FOV: 45 degrees:
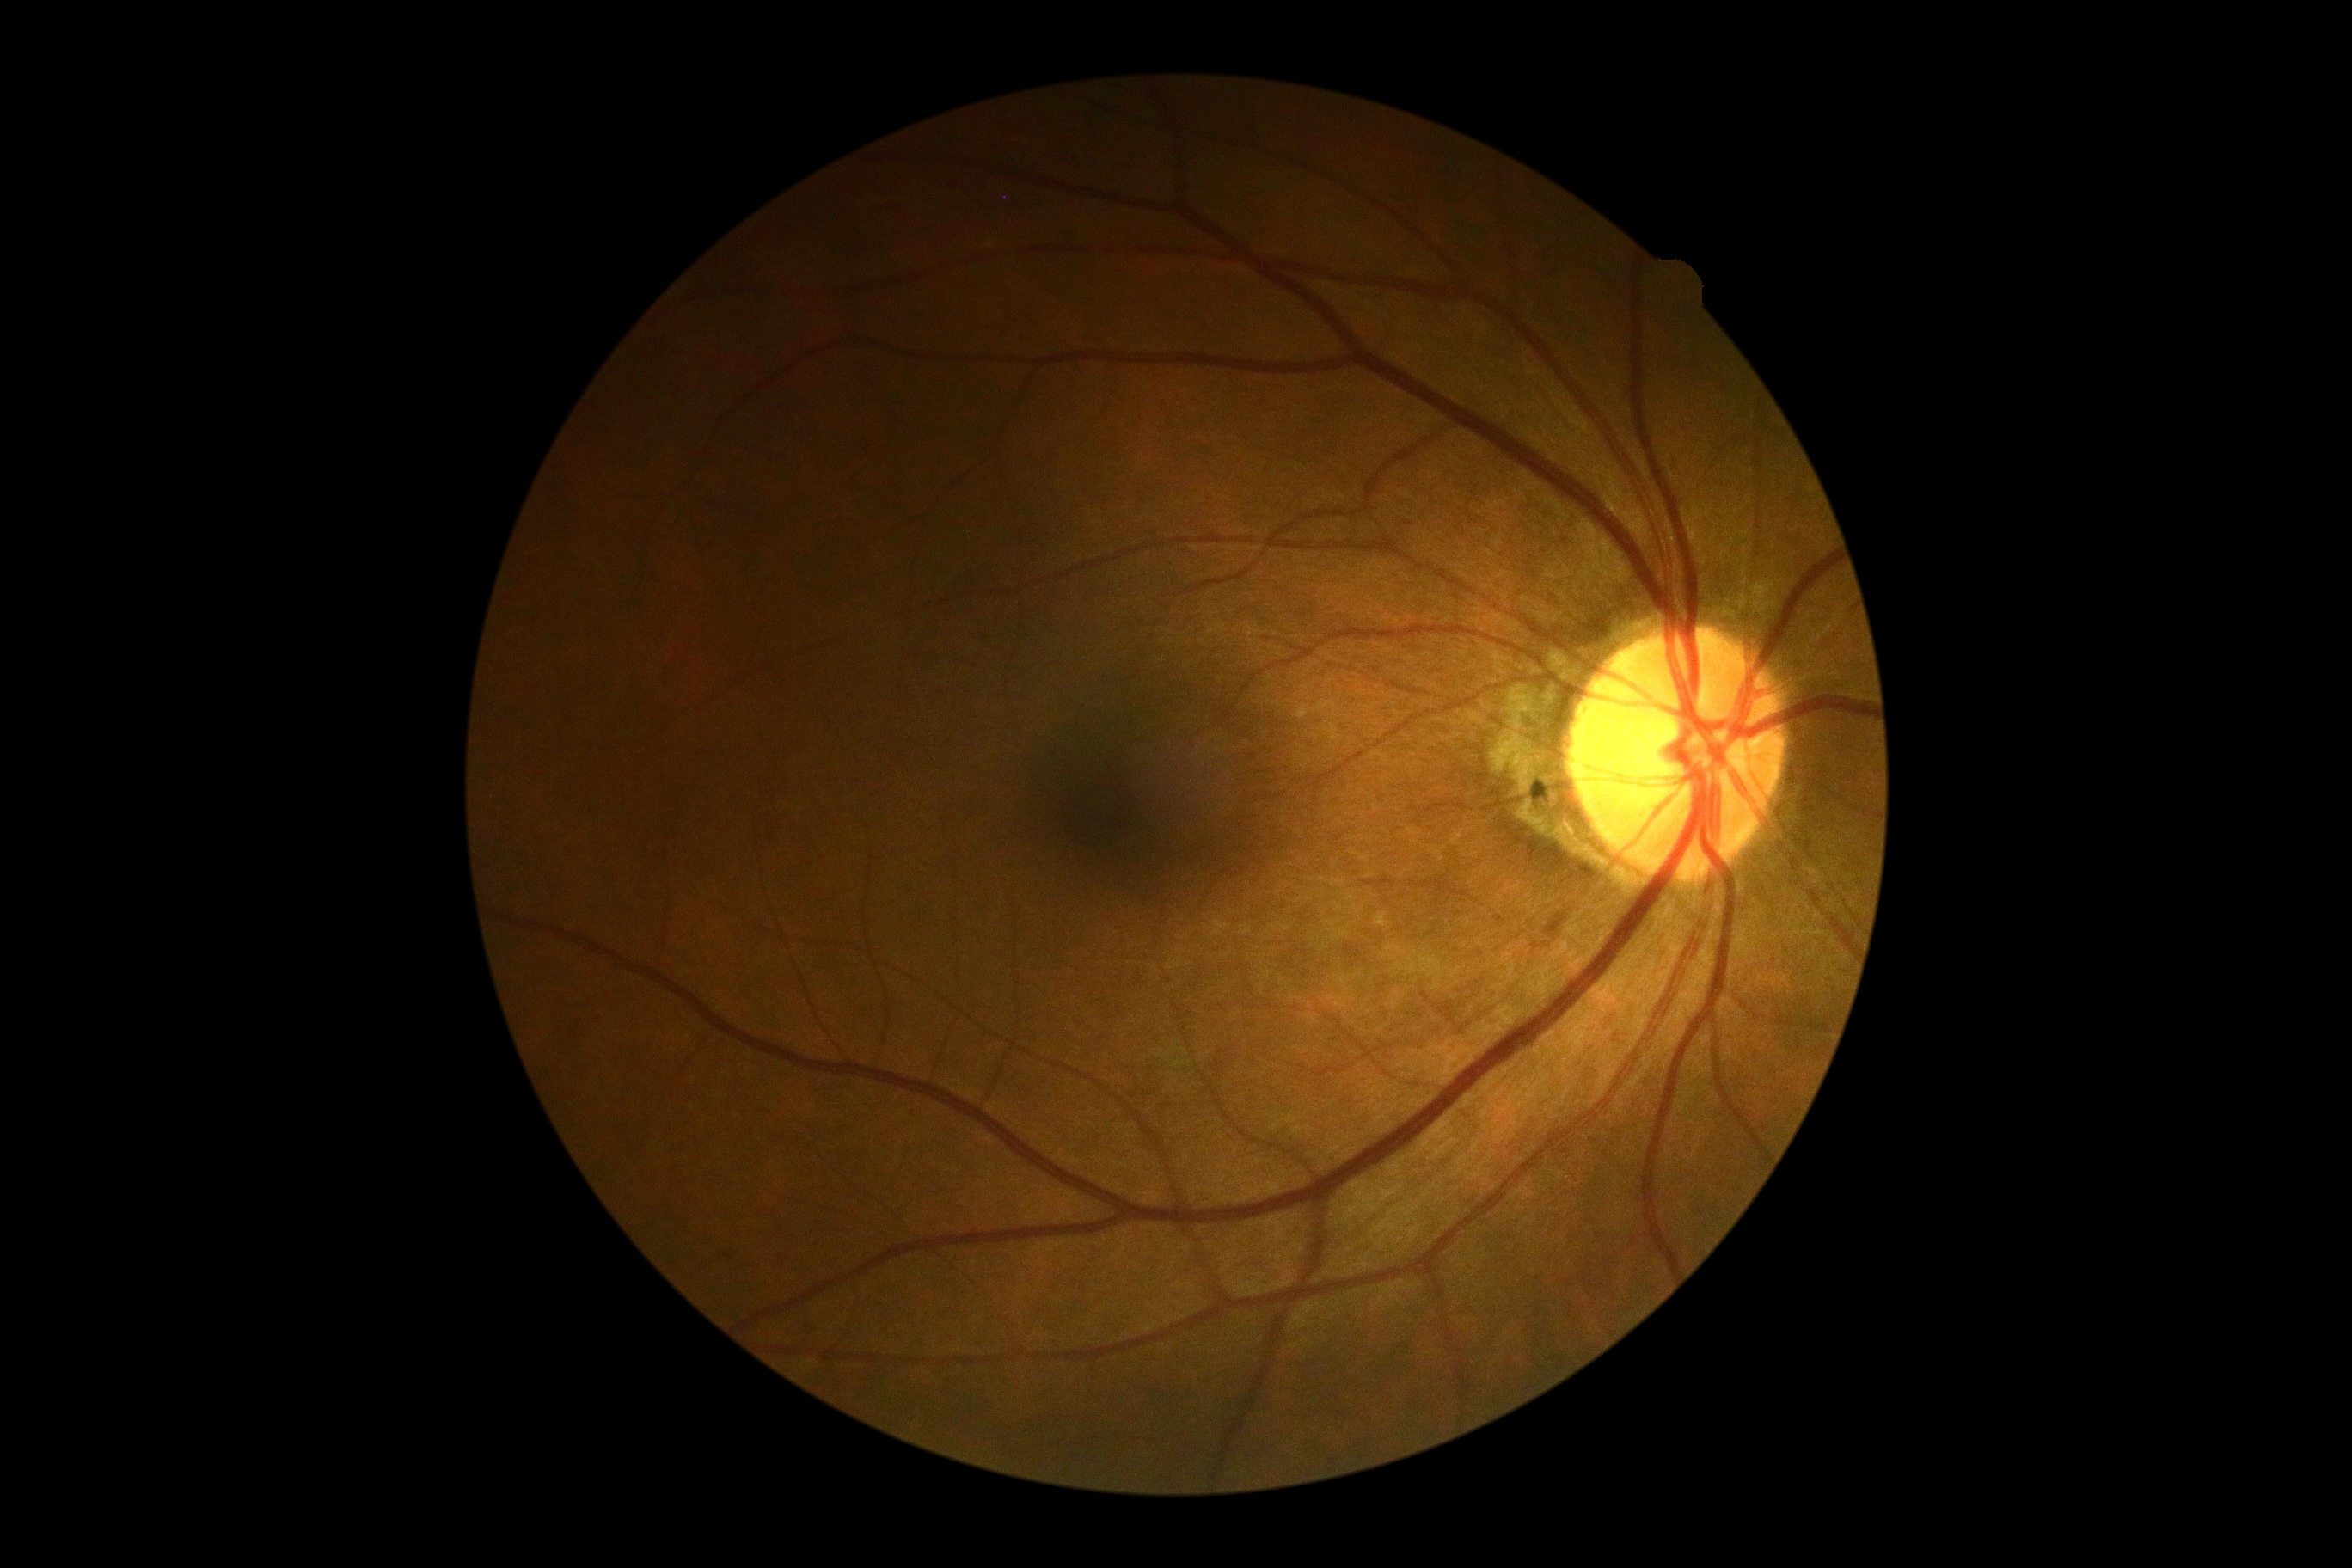
No signs of diabetic retinopathy. Diabetic retinopathy (DR): no apparent retinopathy (grade 0).